240x240px; non-mydriatic acquisition.
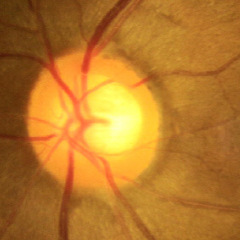 This fundus photograph shows no evidence of glaucoma.